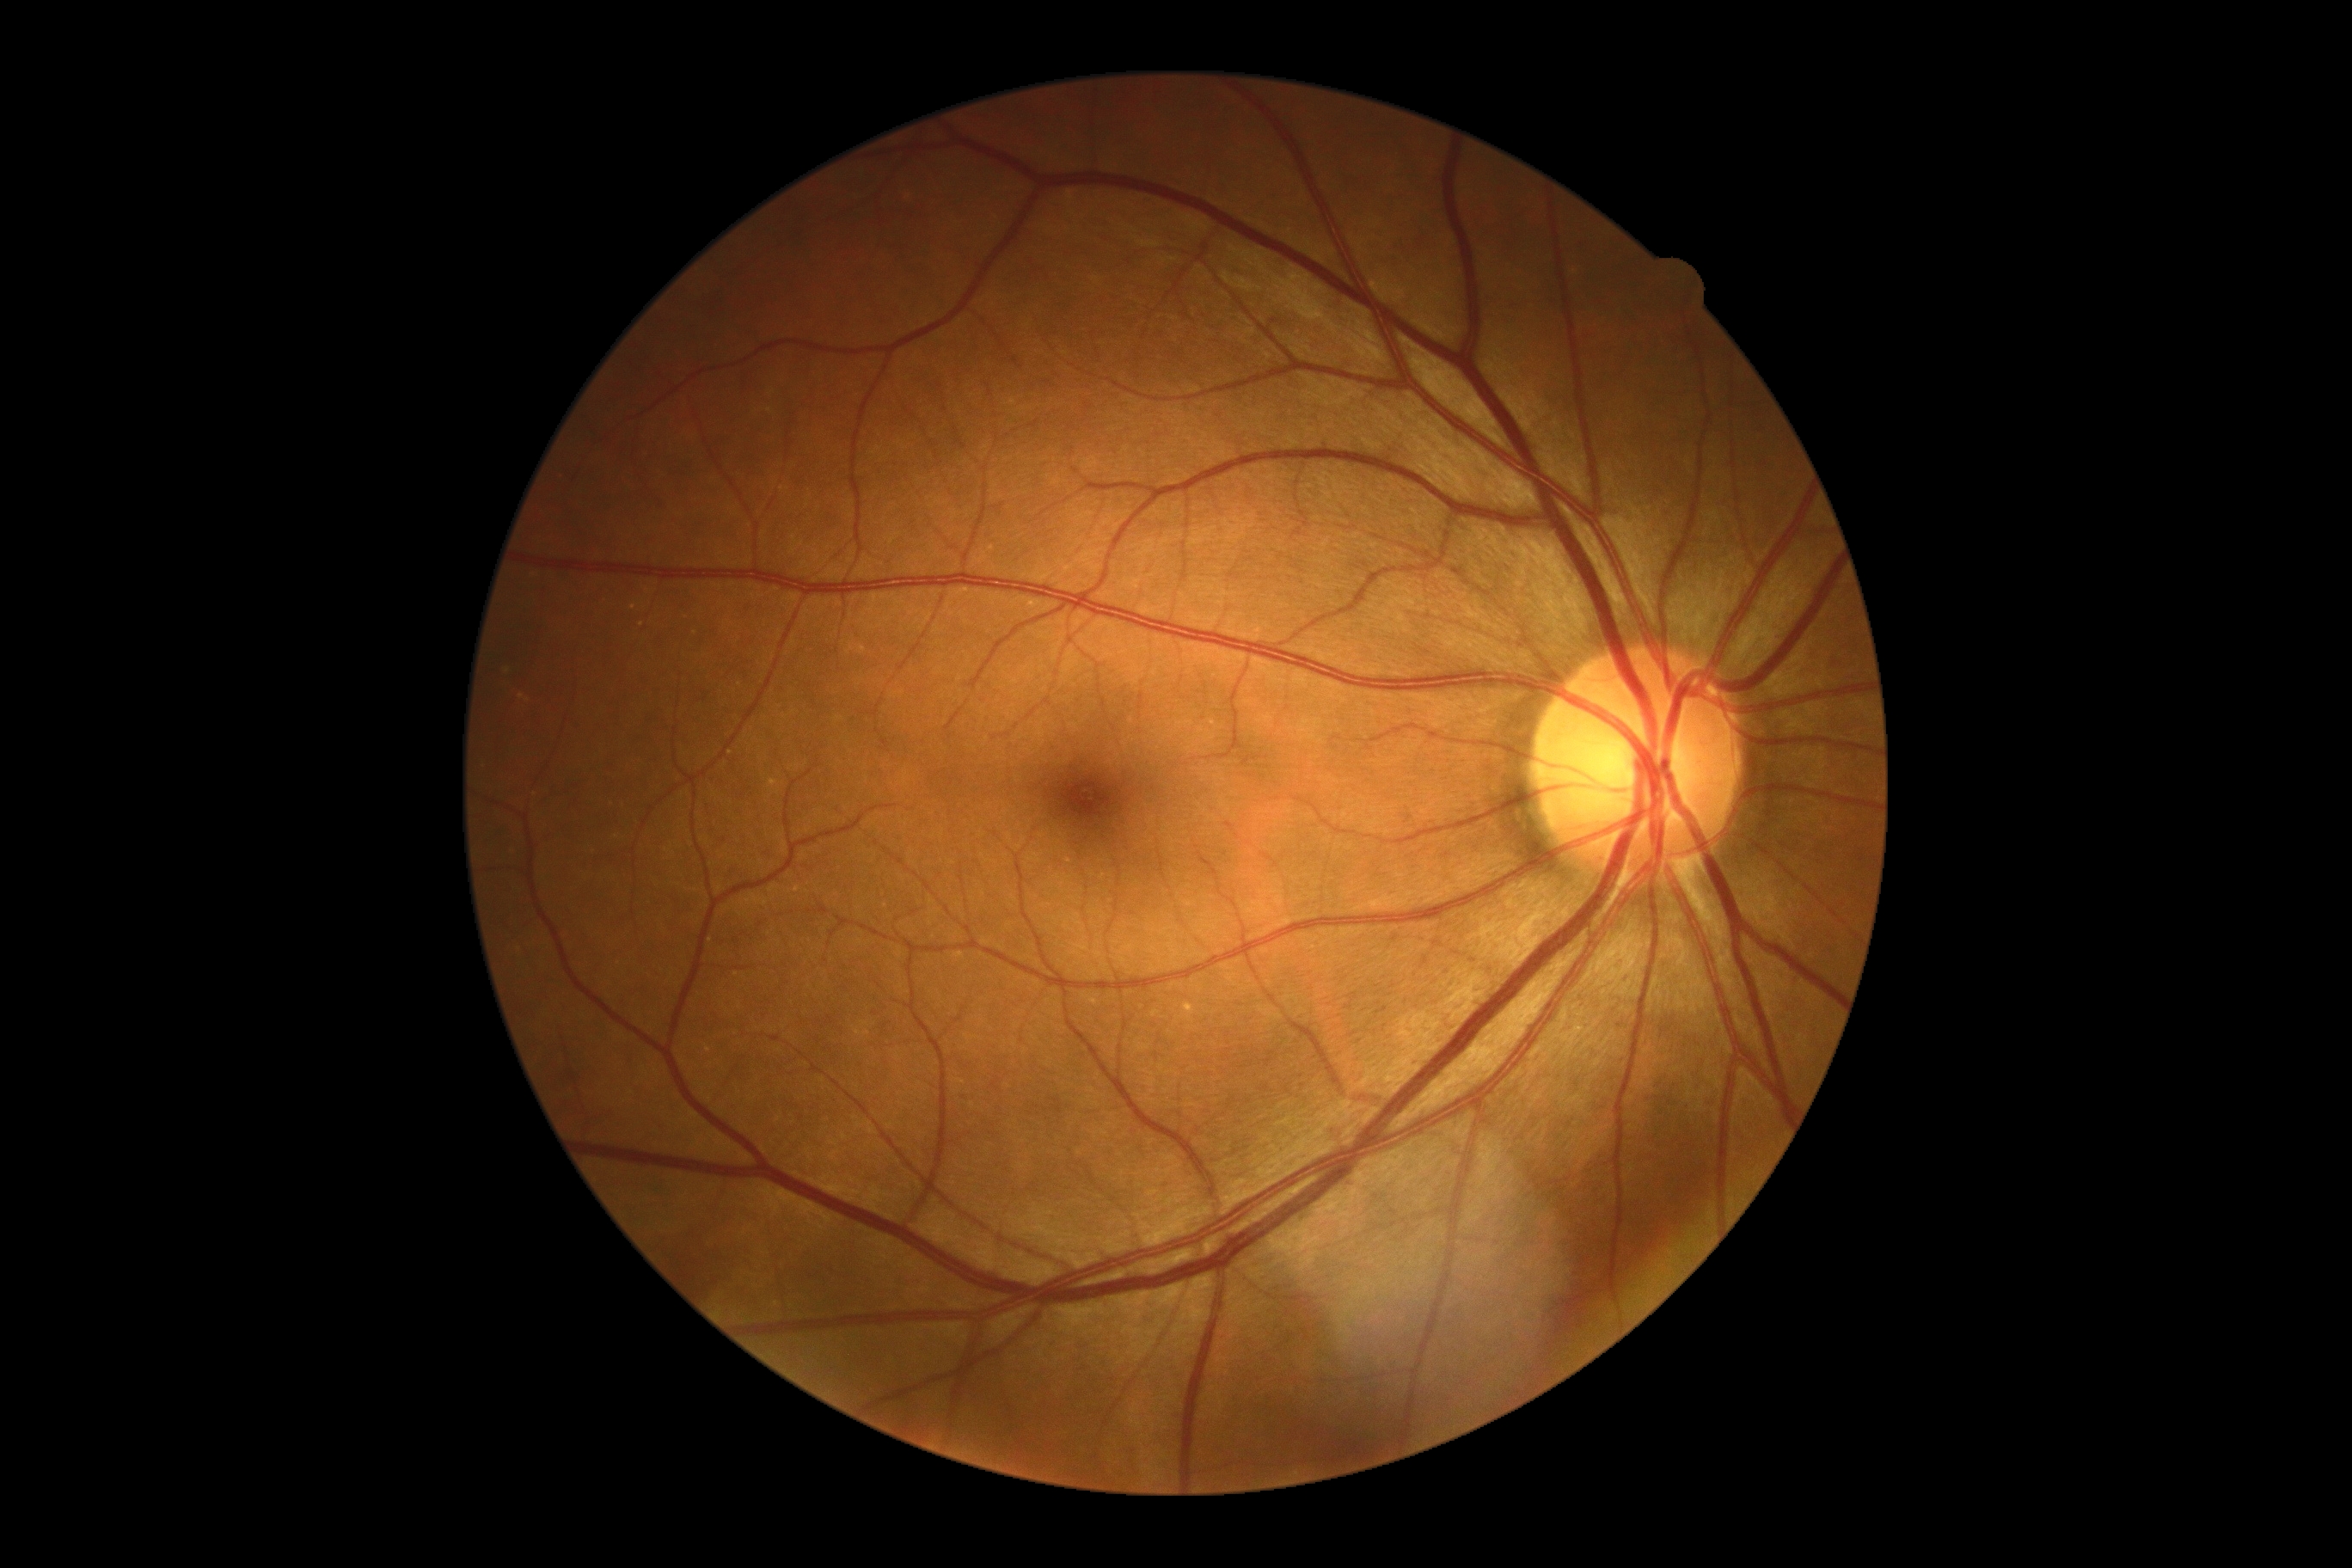 DR impression@negative for DR, retinopathy grade@no apparent diabetic retinopathy (0).